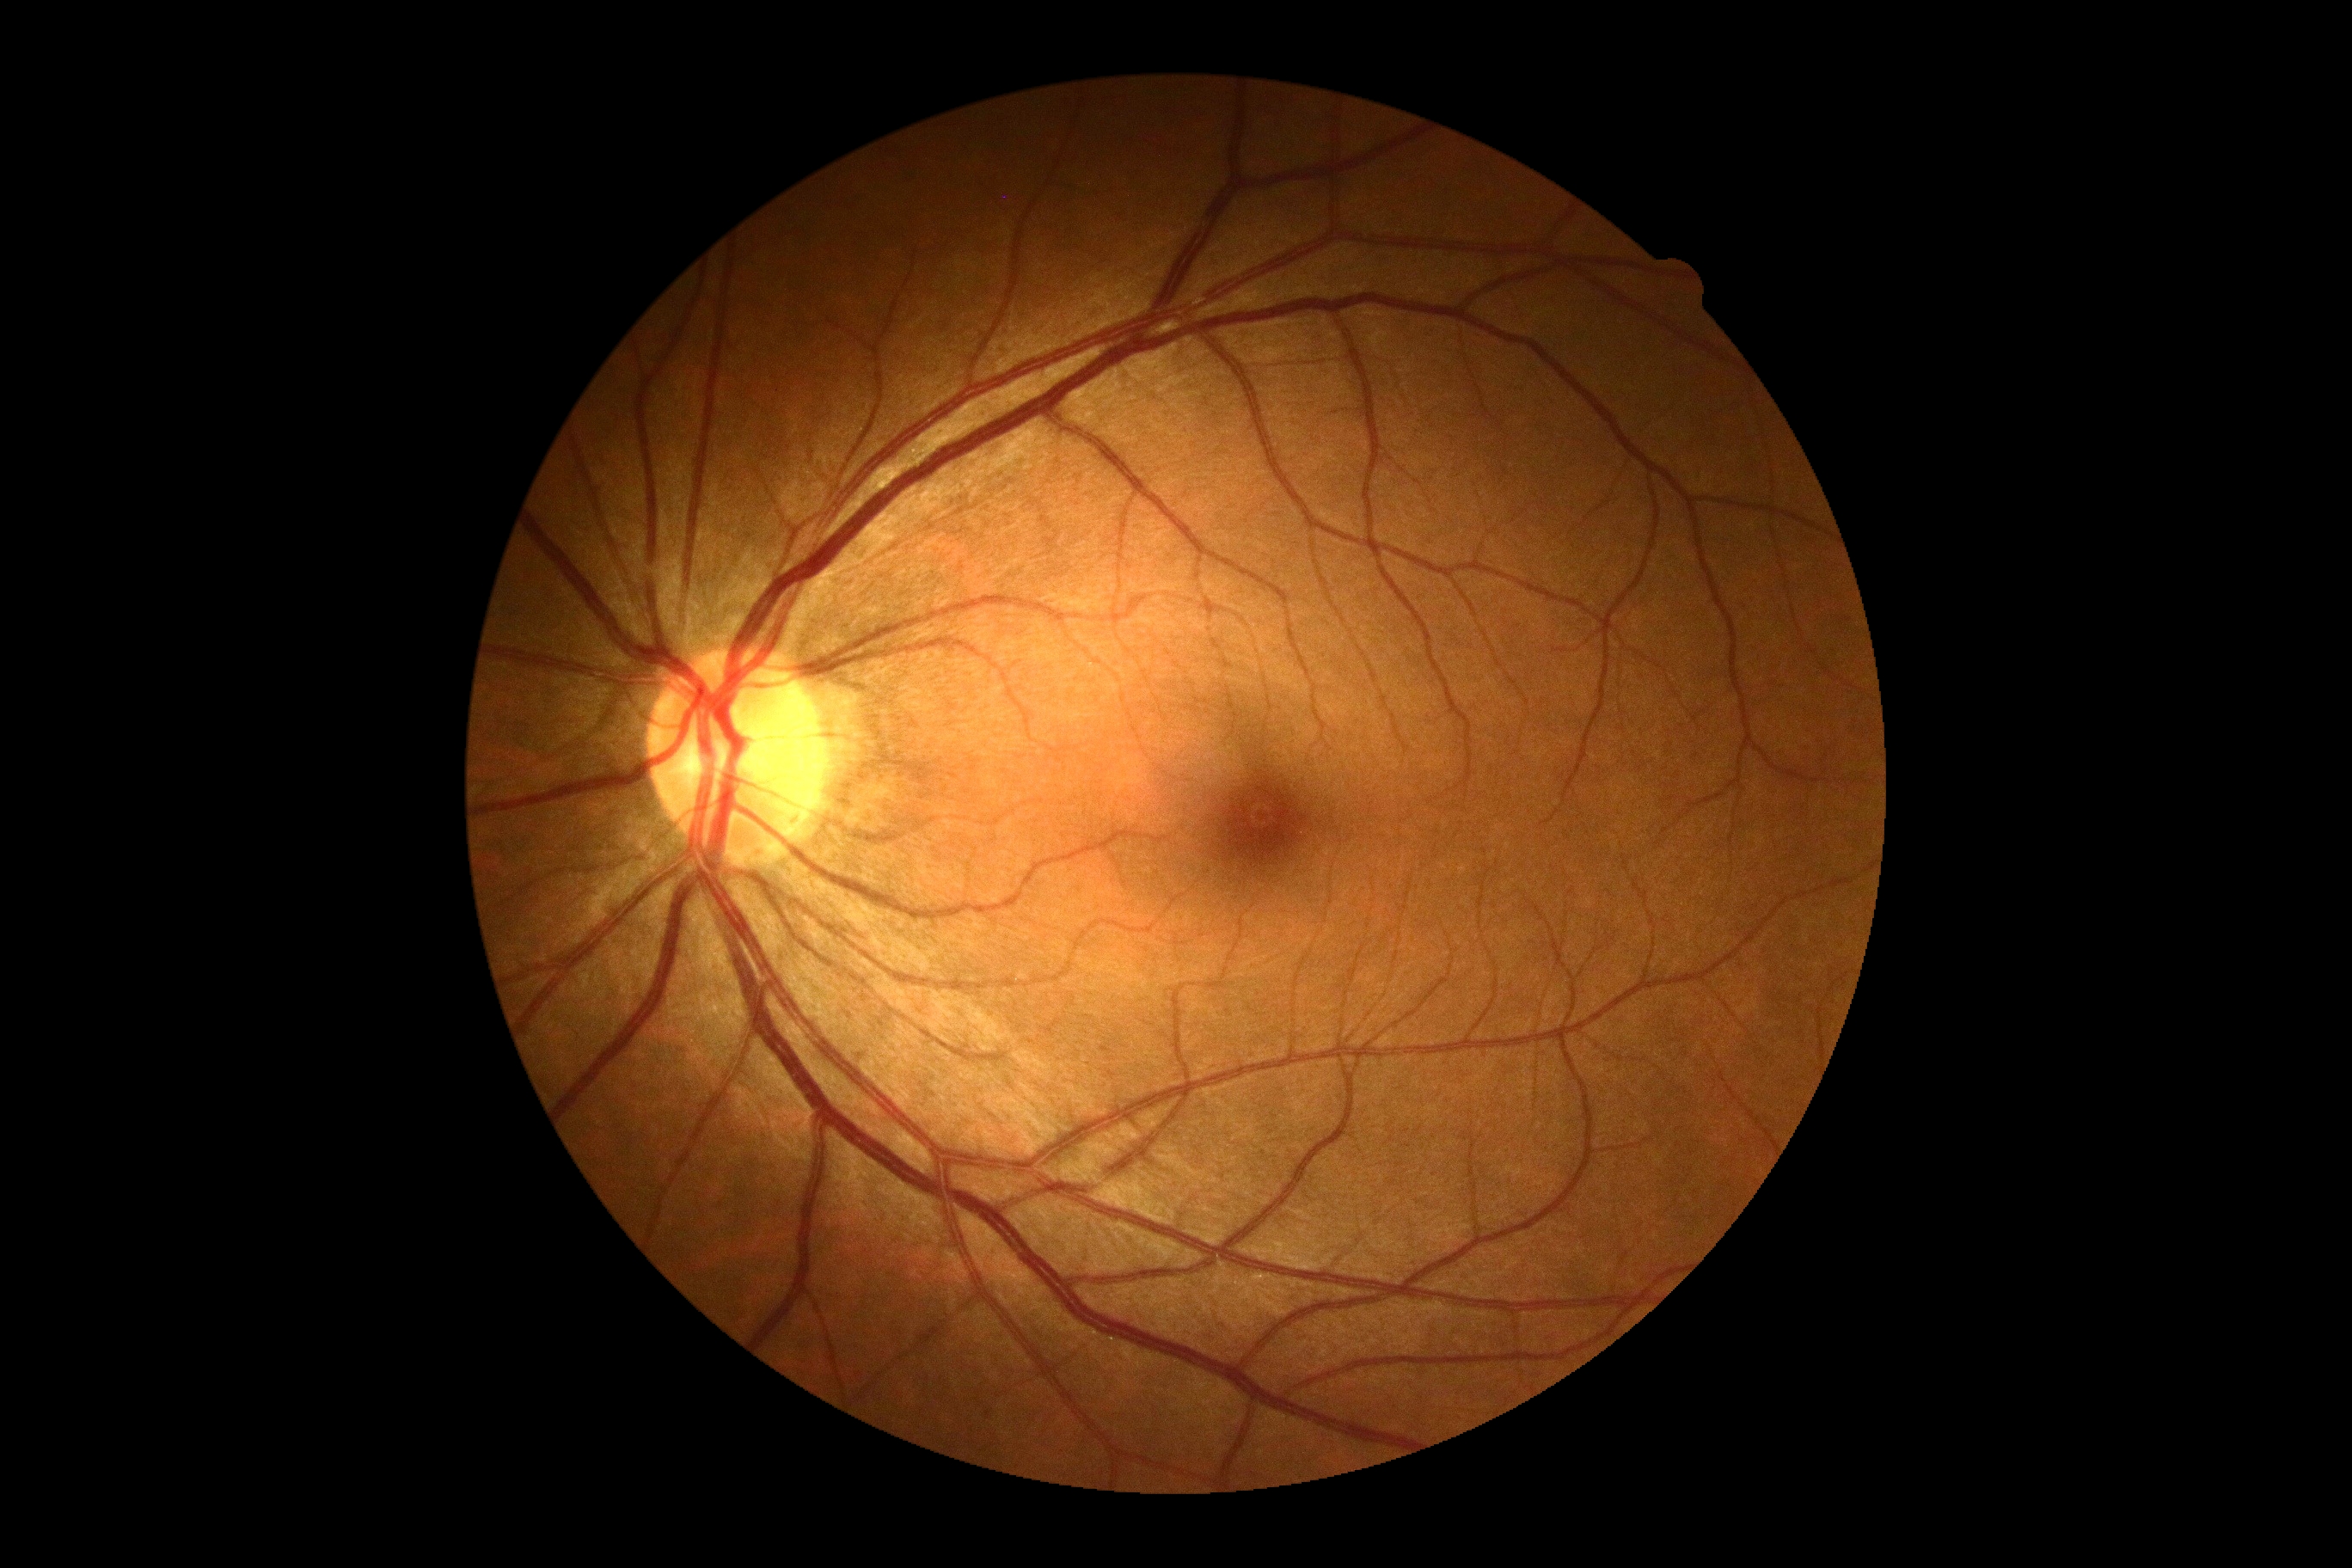 DR: no apparent diabetic retinopathy (grade 0).